Acquired on the Natus RetCam Envision. Infant wide-field retinal image. Image size 1440x1080
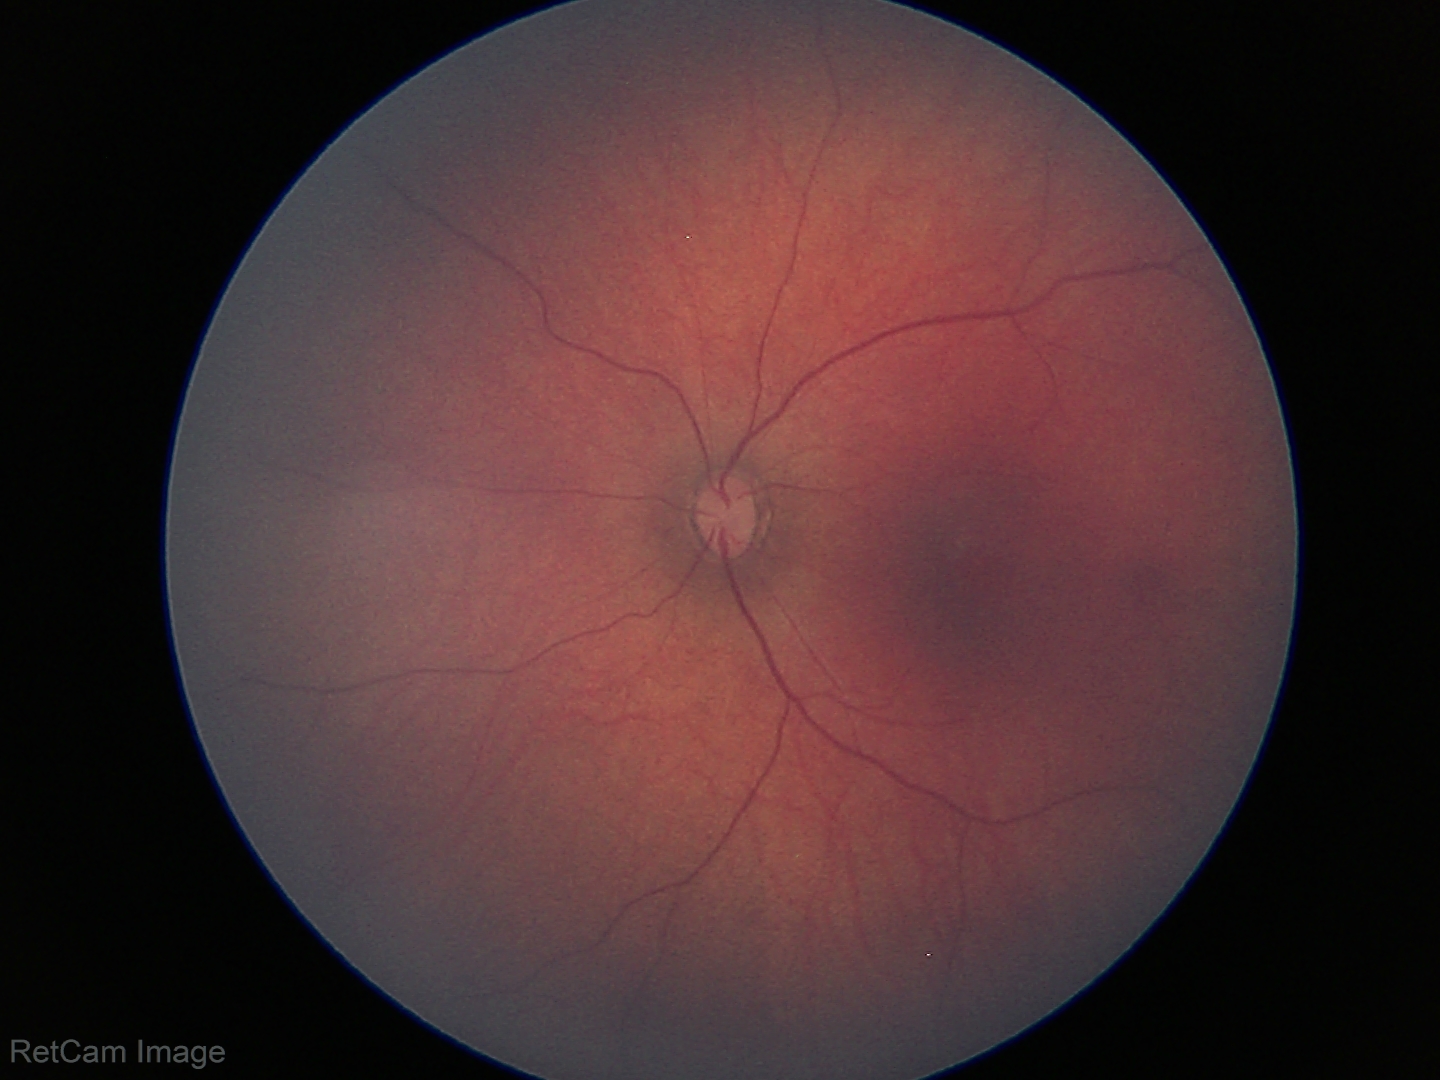
Examination with physiological retinal findings.